Dilated-pupil acquisition.
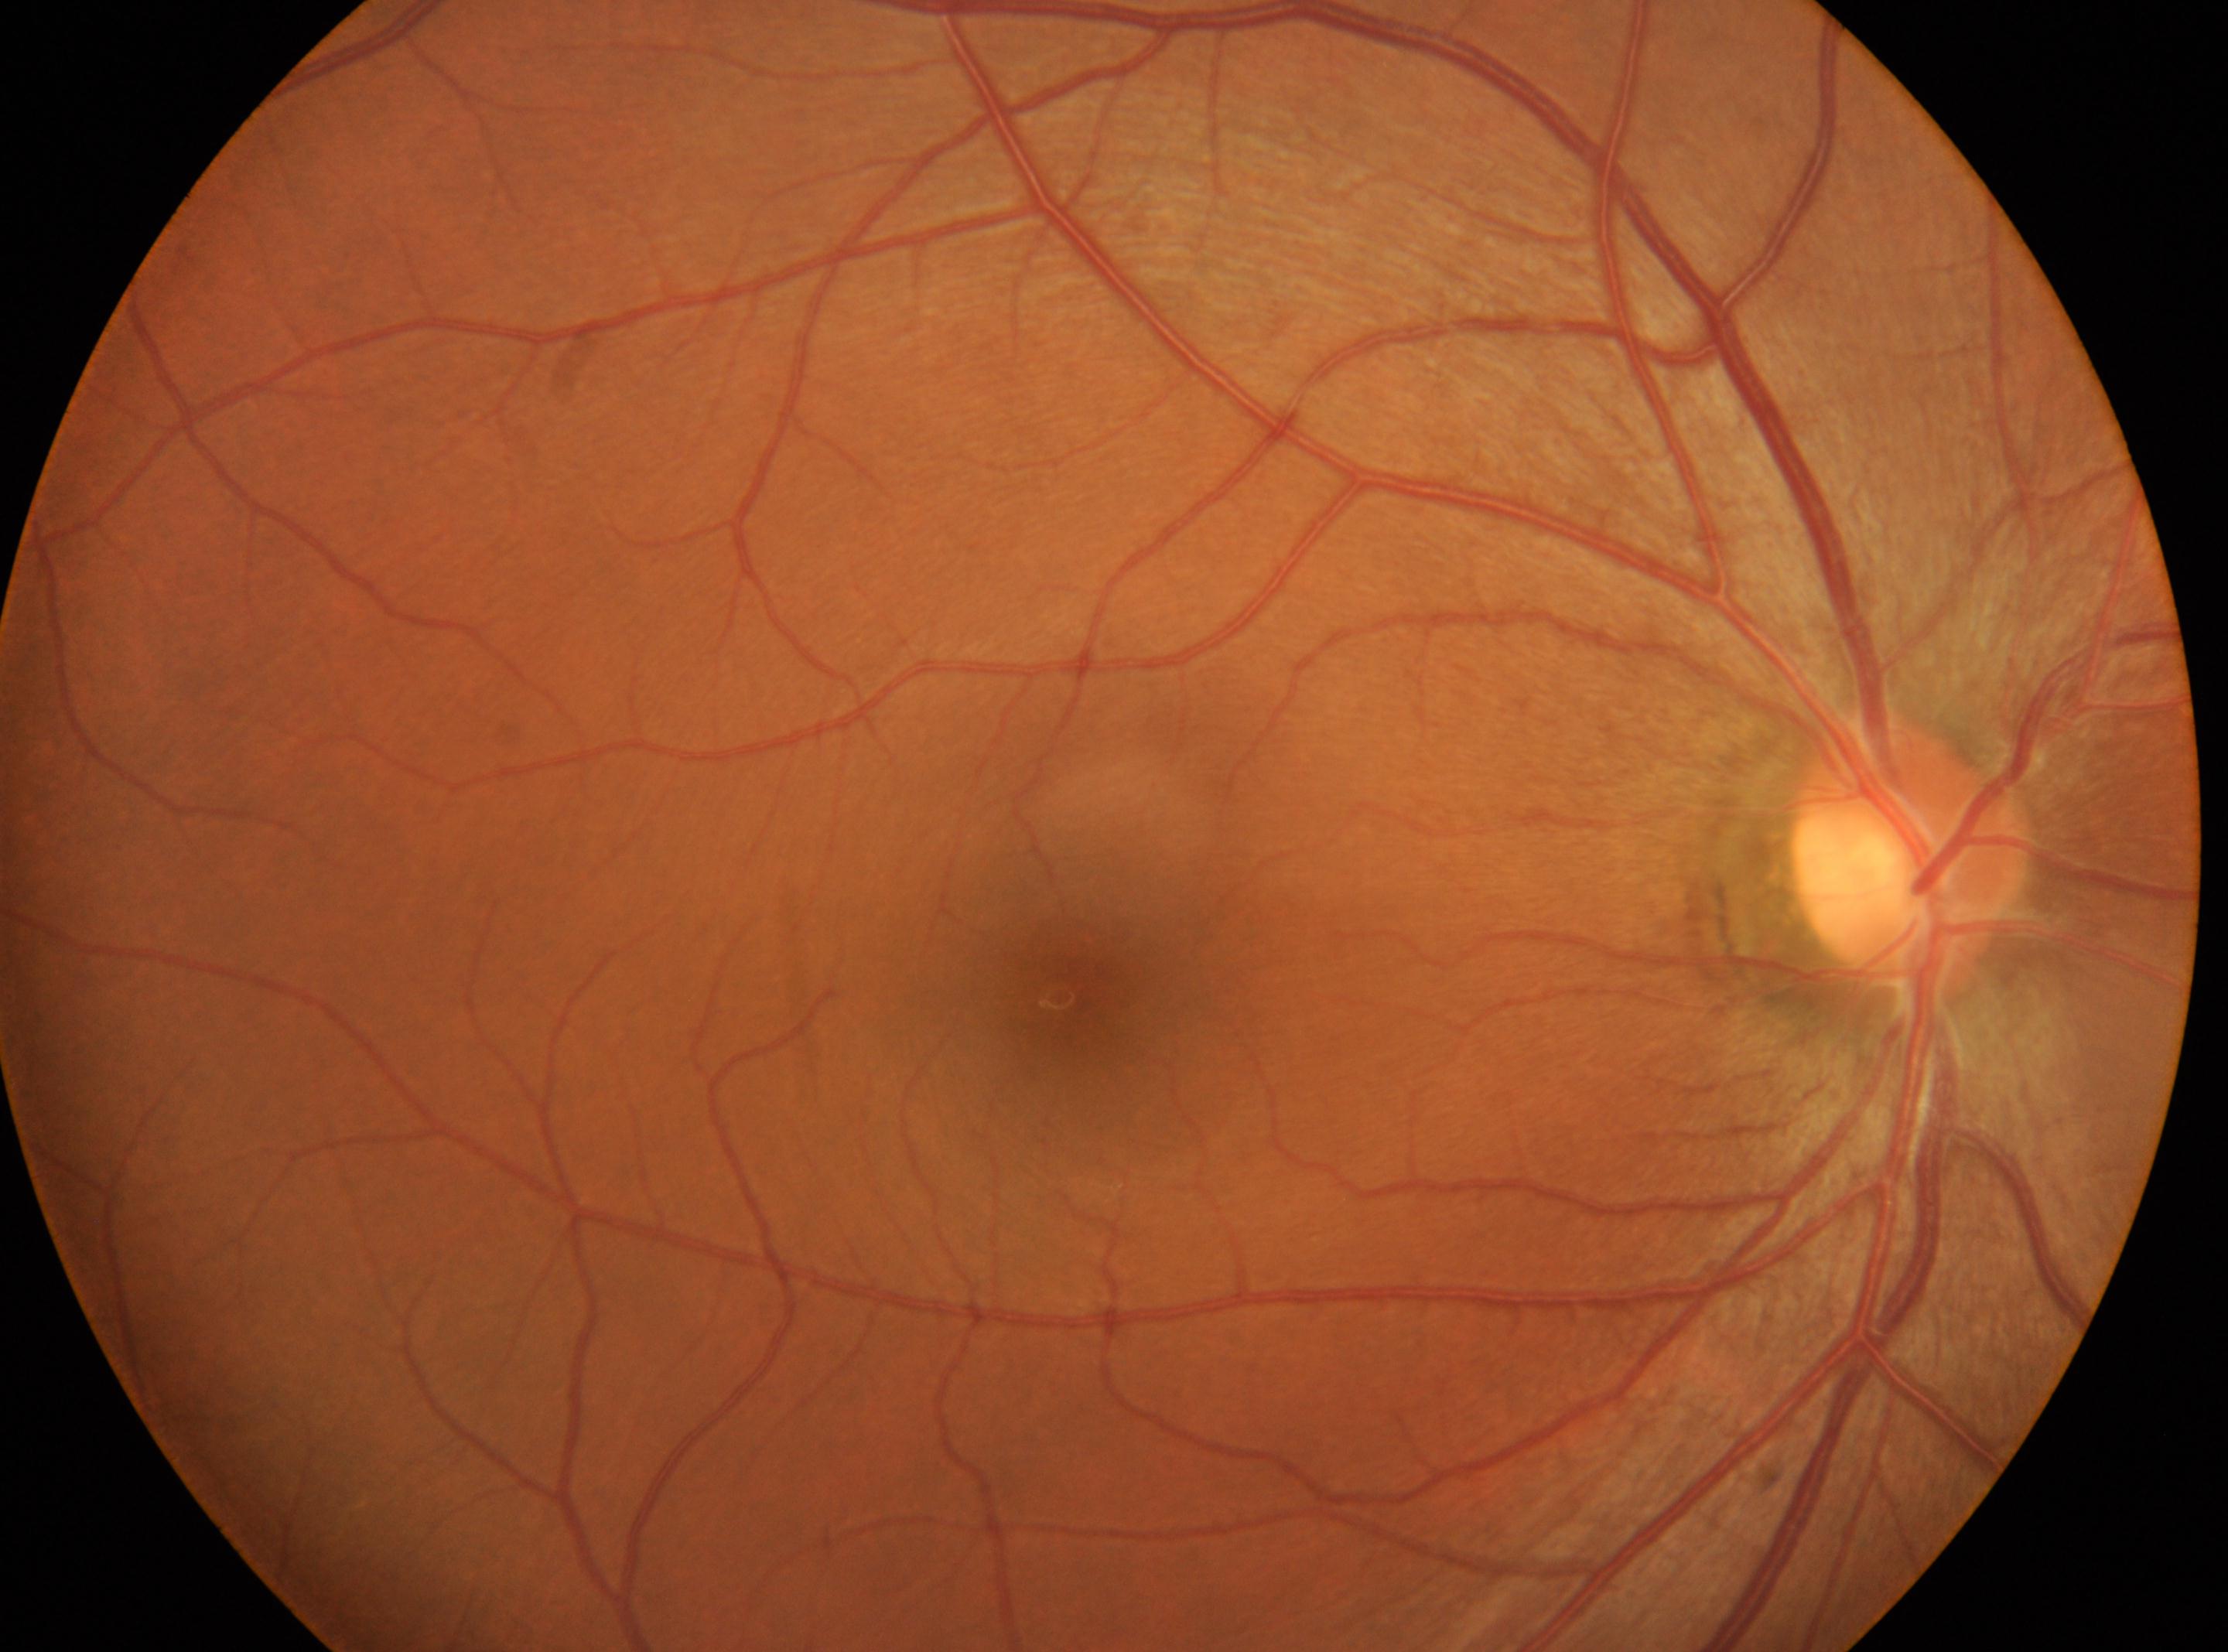

Annotations:
- laterality · oculus dexter
- DR stage · grade 0 (no apparent retinopathy)
- optic disk · (x: 1906, y: 846)
- macula center · (x: 1058, y: 996)